Retinal fundus photograph — 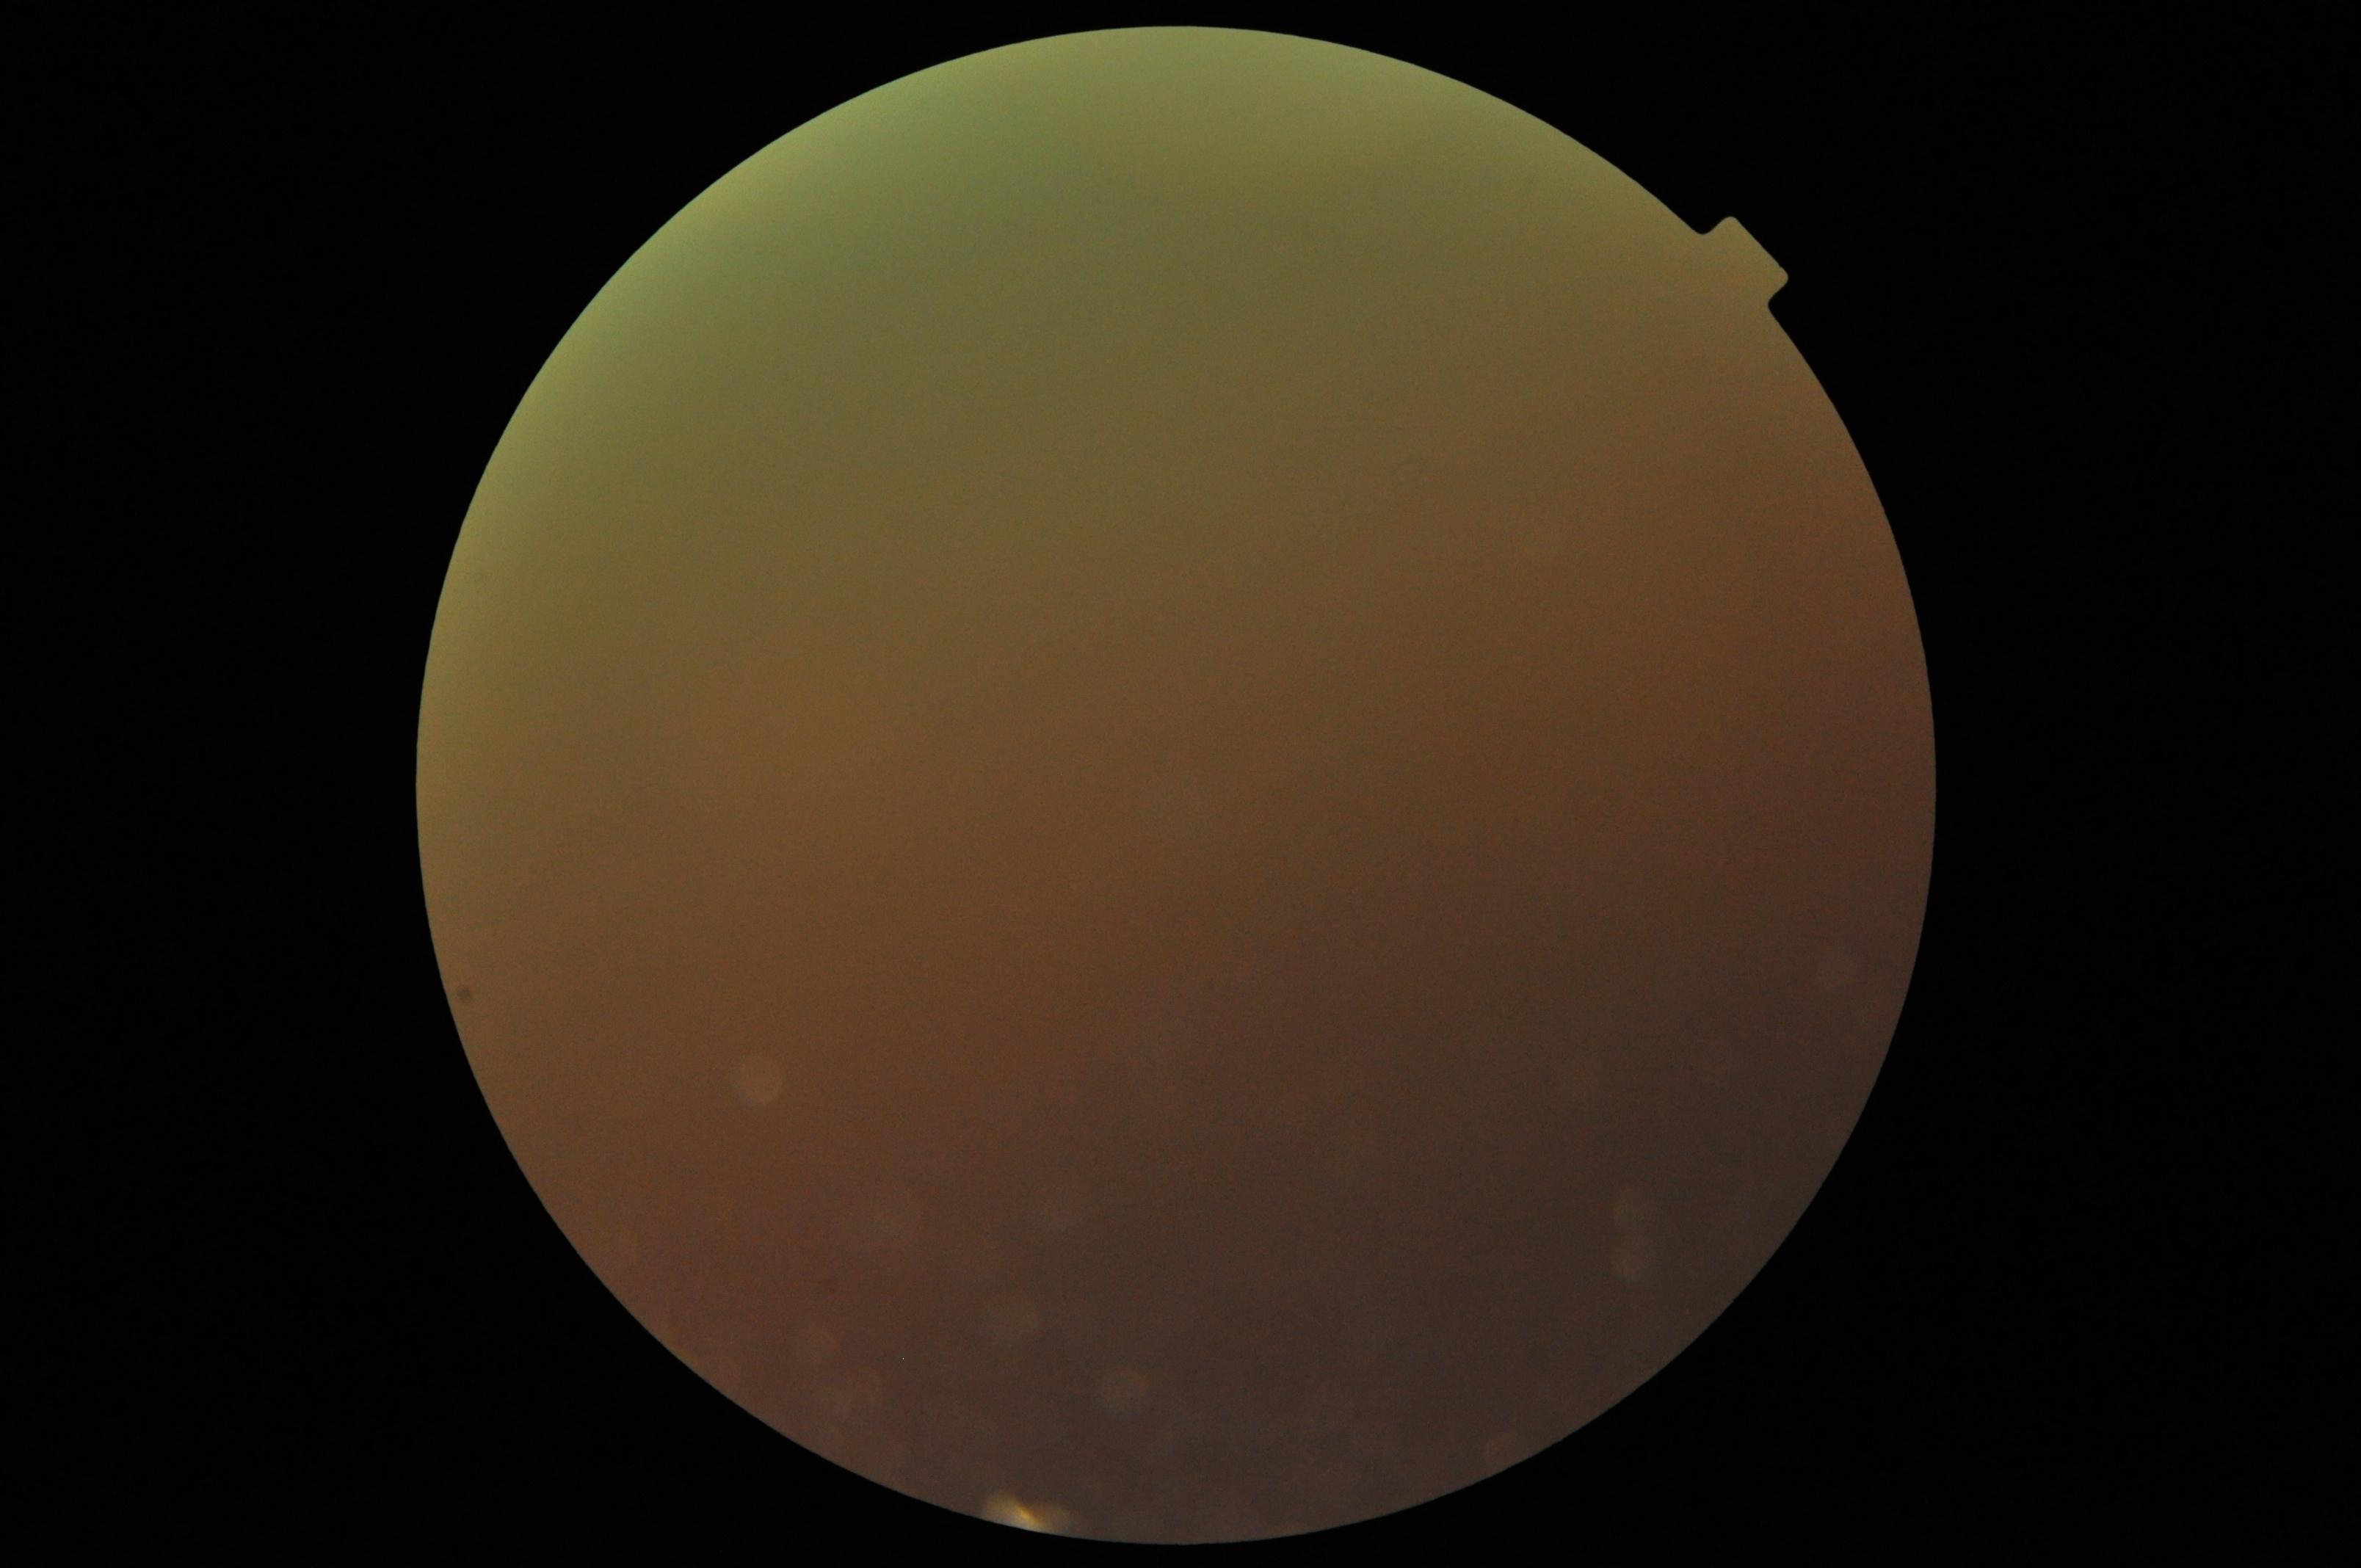
DR is ungradable due to poor image quality.